Wide-field contact fundus photograph of an infant.
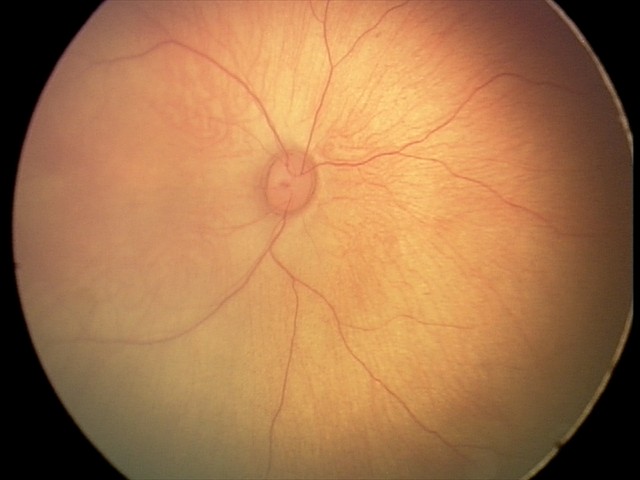 Screening examination consistent with retinal hemorrhages.